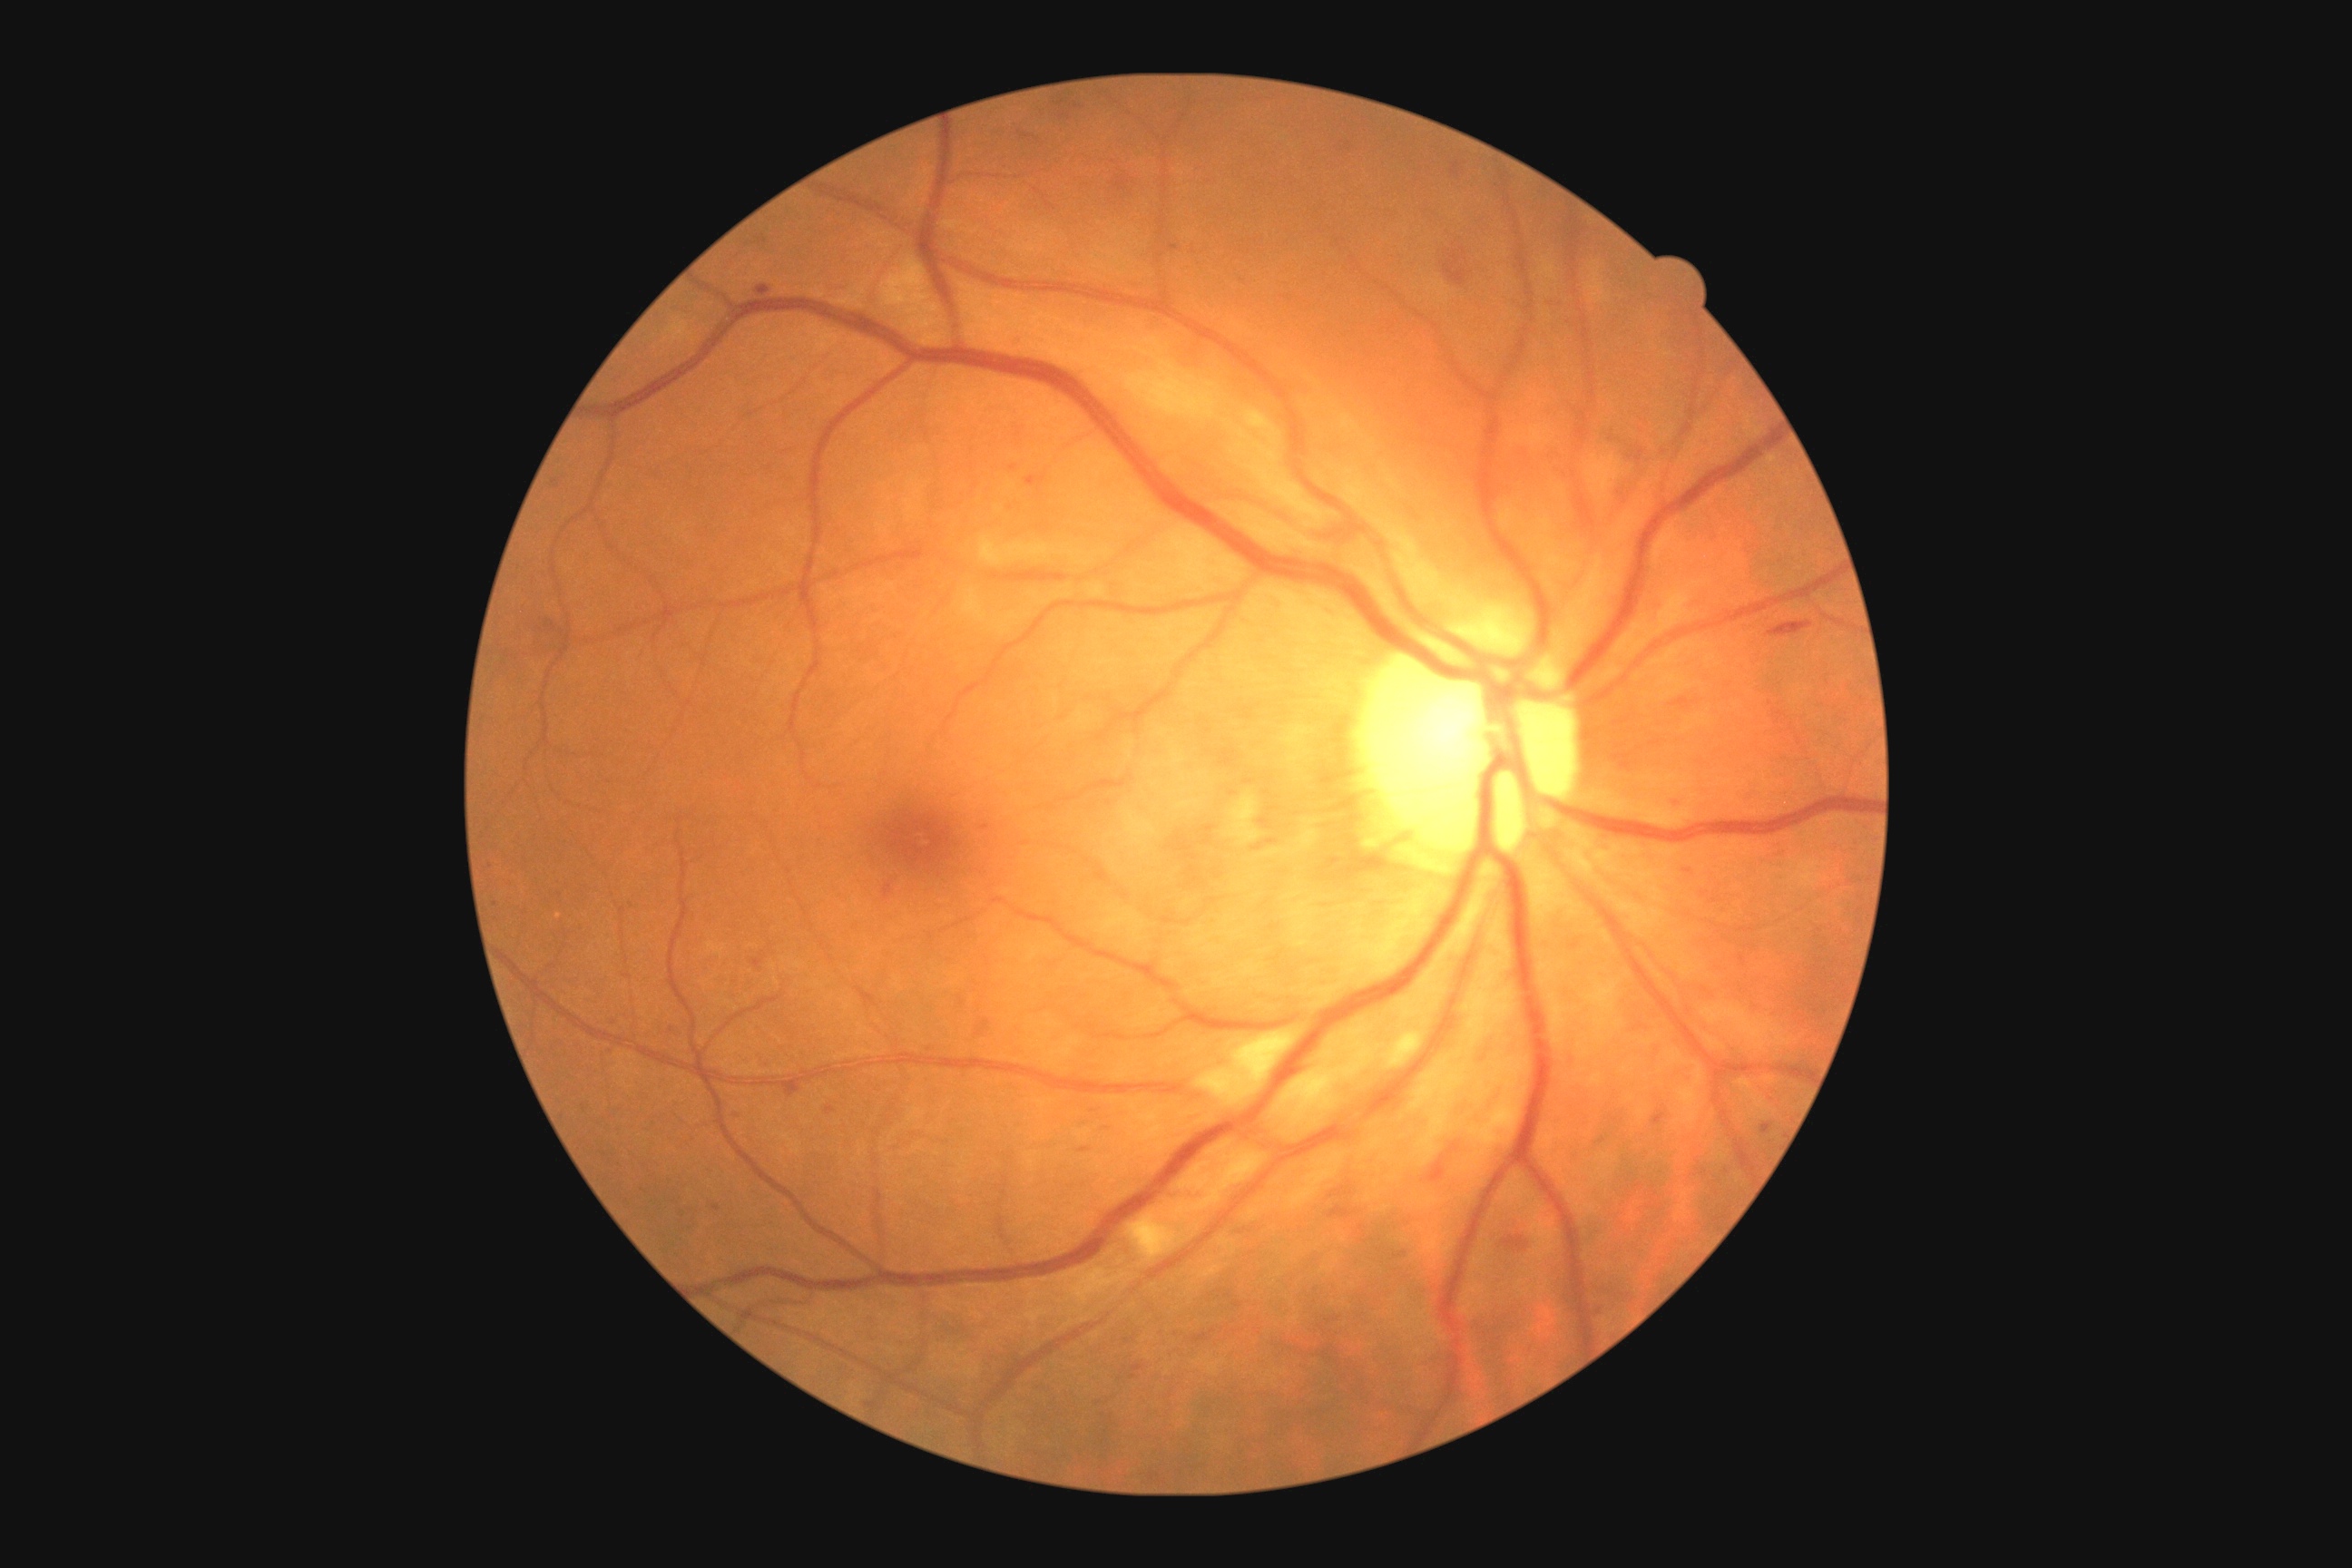 diabetic retinopathy (DR)@grade 2 (moderate NPDR), DR class@non-proliferative diabetic retinopathy.